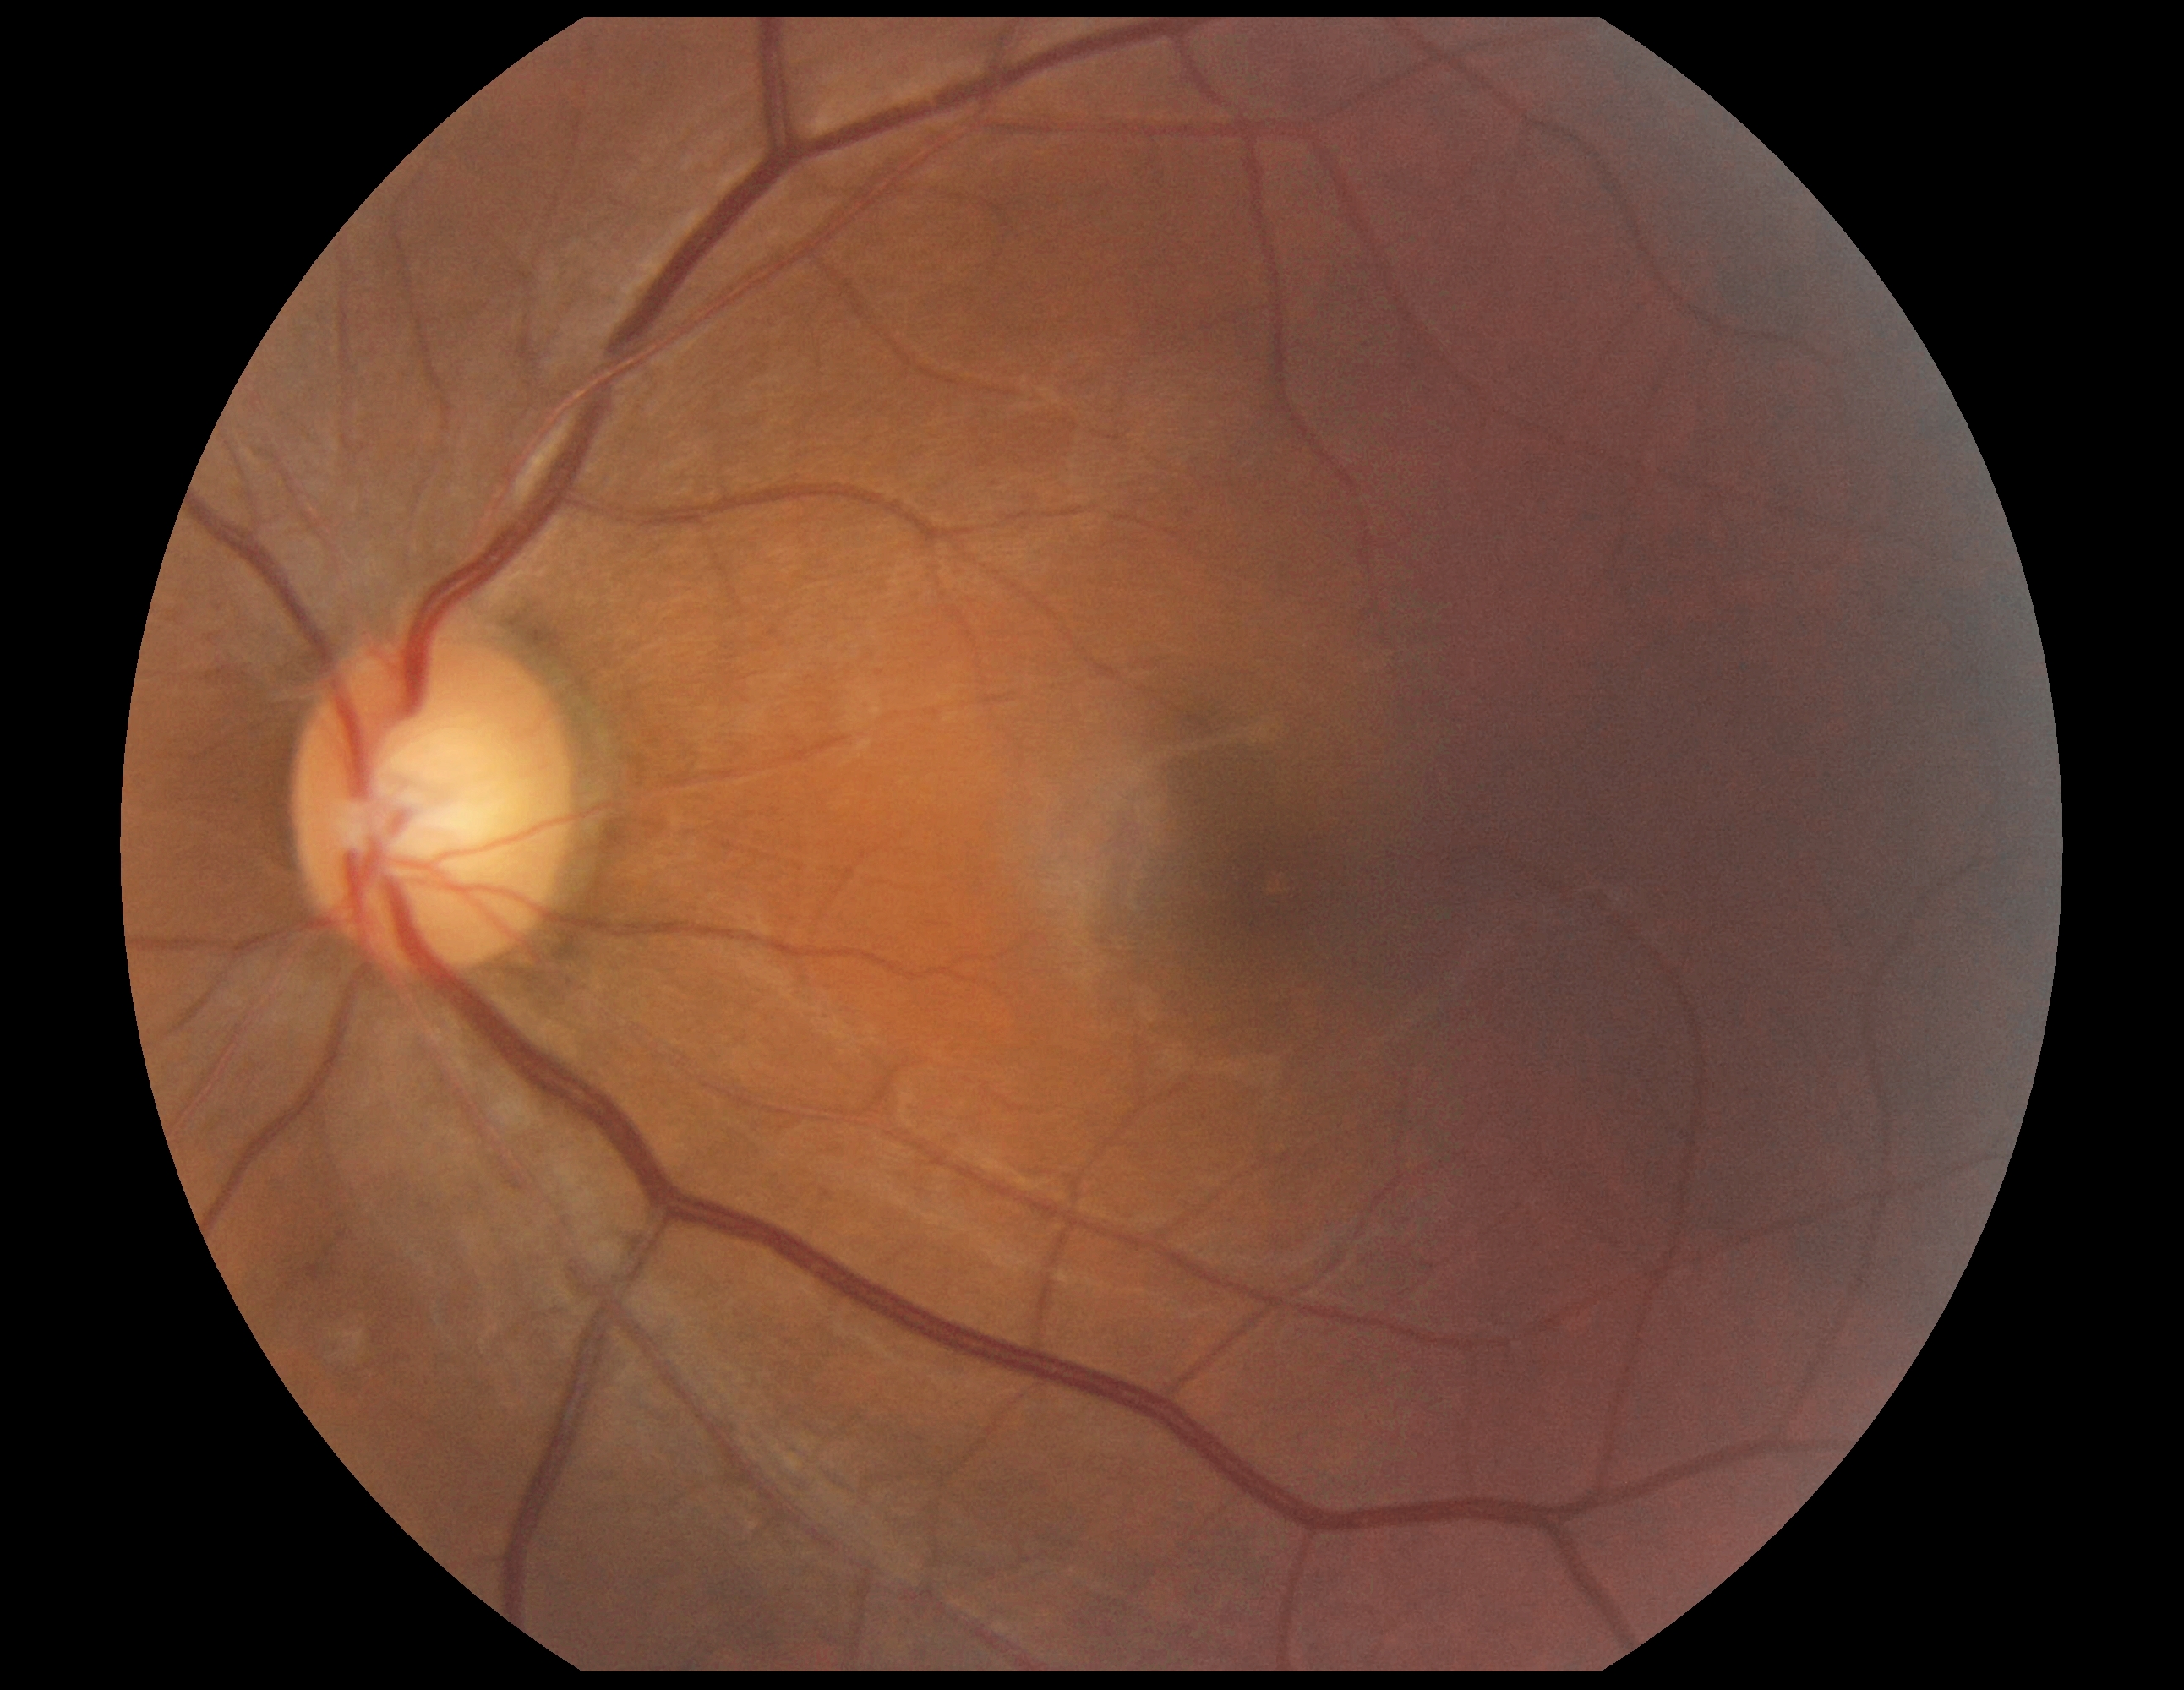

- DR: no apparent retinopathy (grade 0)